45-degree field of view — 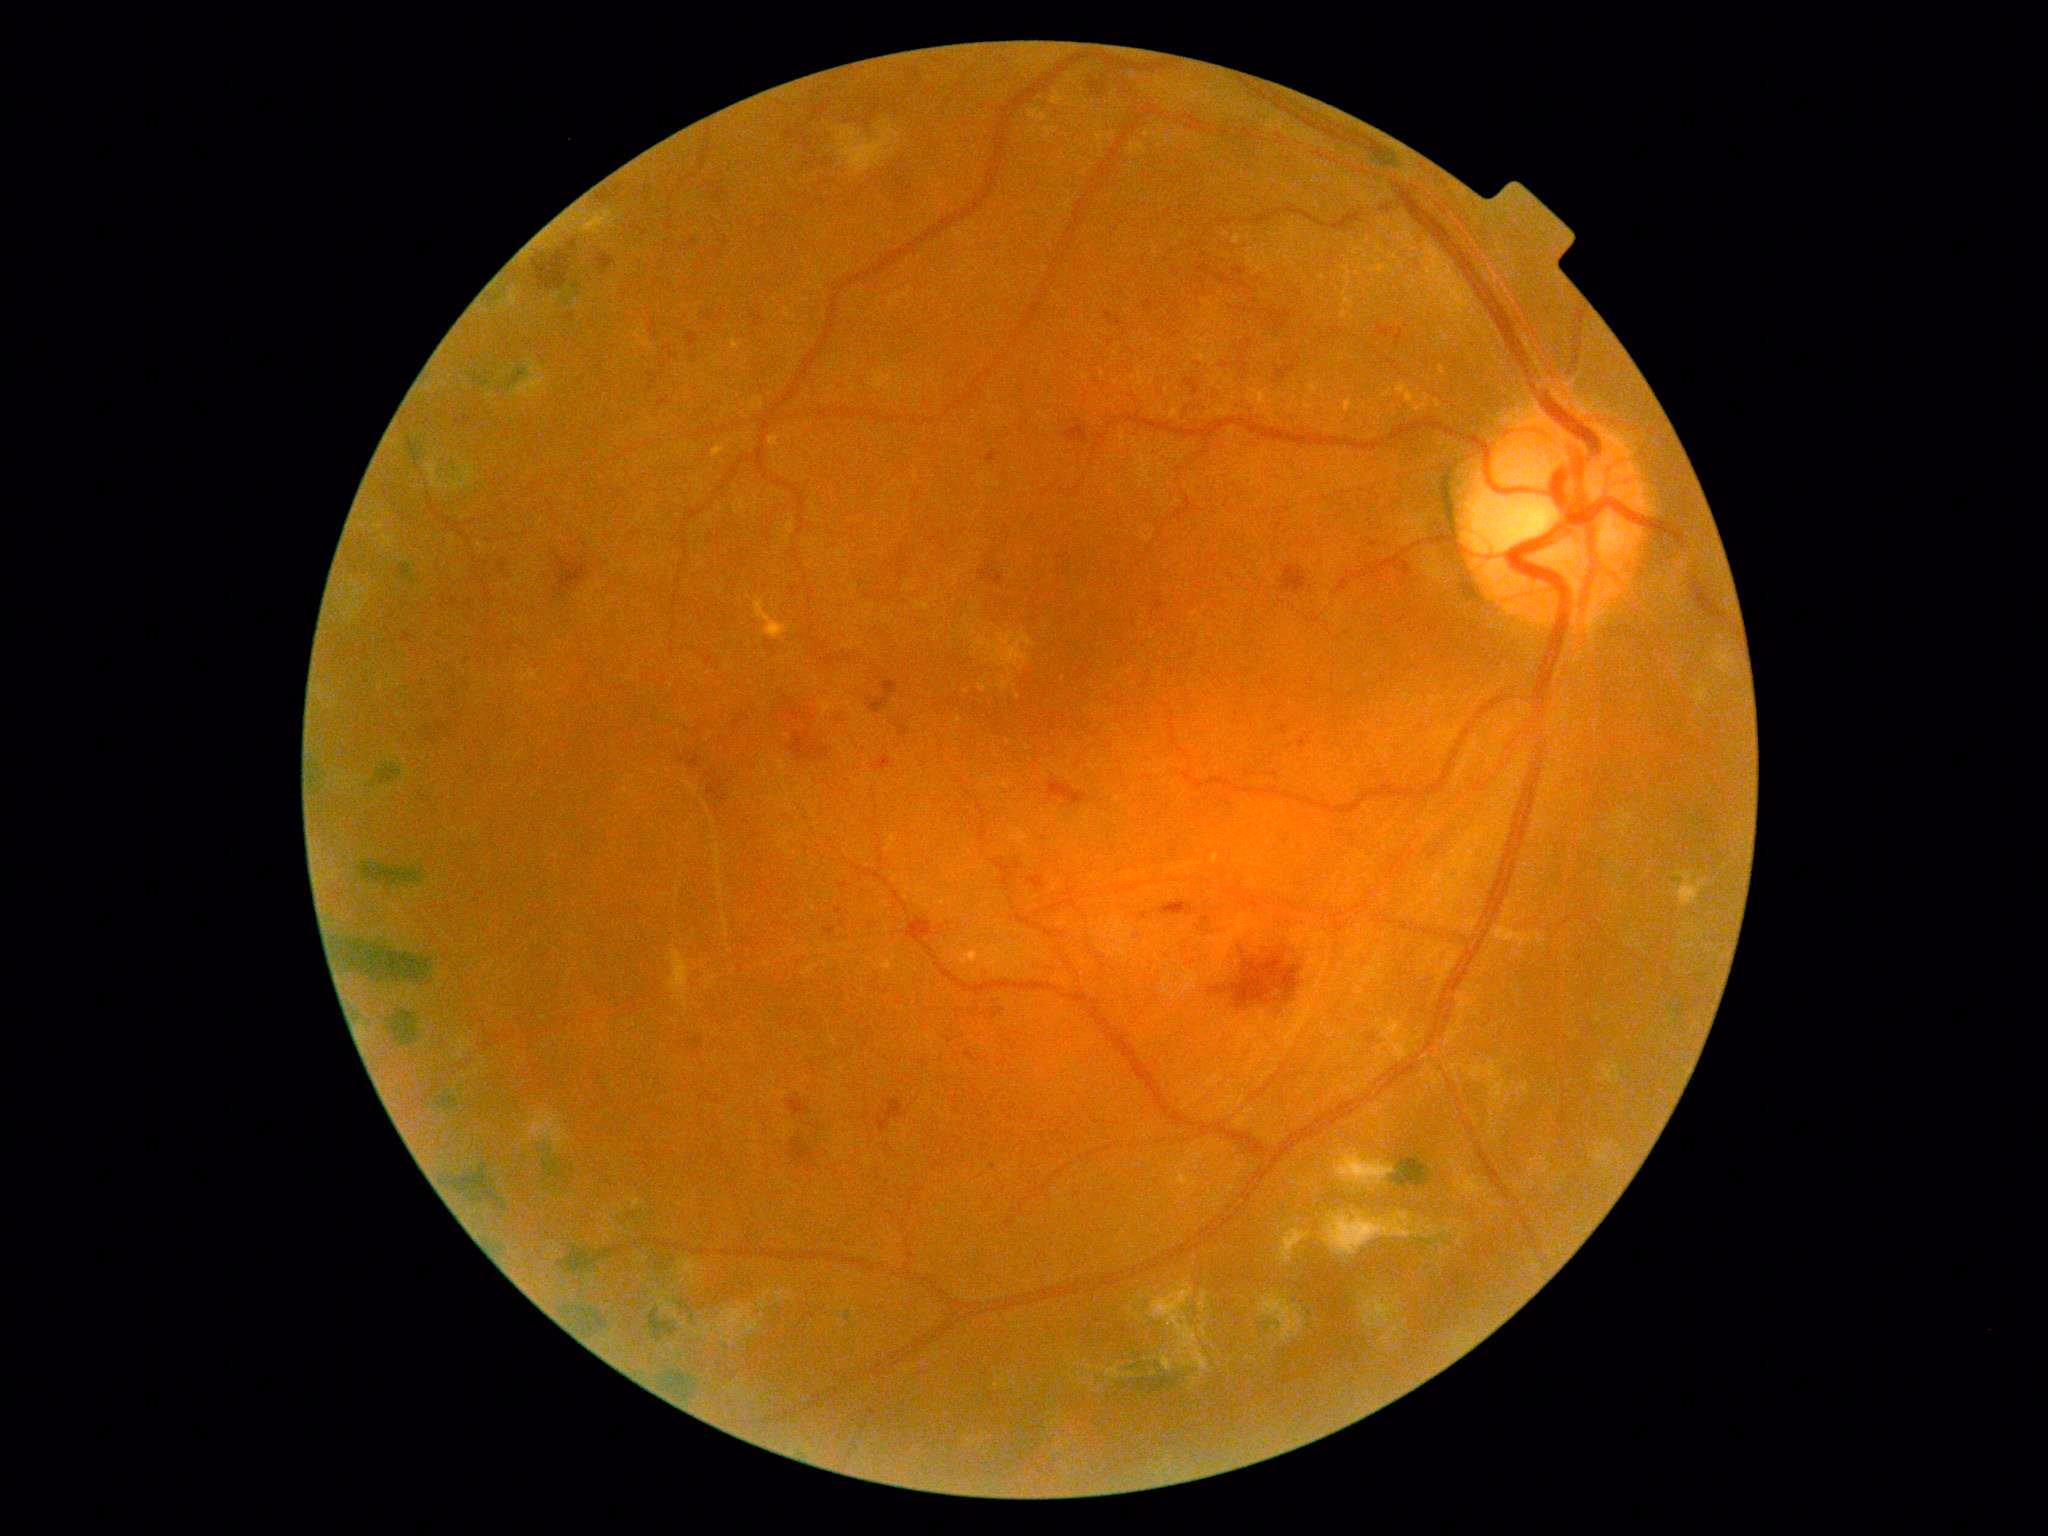 Diabetic retinopathy (DR) is grade 3 (severe NPDR) — more than 20 intraretinal hemorrhages in each of 4 quadrants, definite venous beading in 2 or more quadrants, or prominent intraretinal microvascular abnormalities in 1 or more quadrants, with no signs of proliferative retinopathy. DR class: non-proliferative diabetic retinopathy.